Wide-field fundus photograph of an infant:
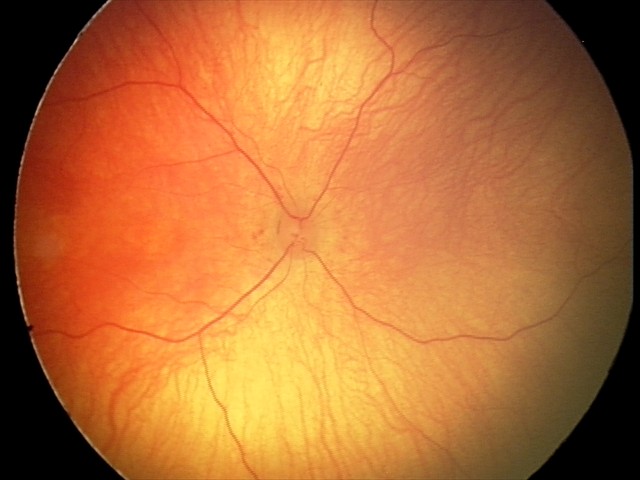
Examination with physiological retinal findings.